45° field of view. 2184x1690 — 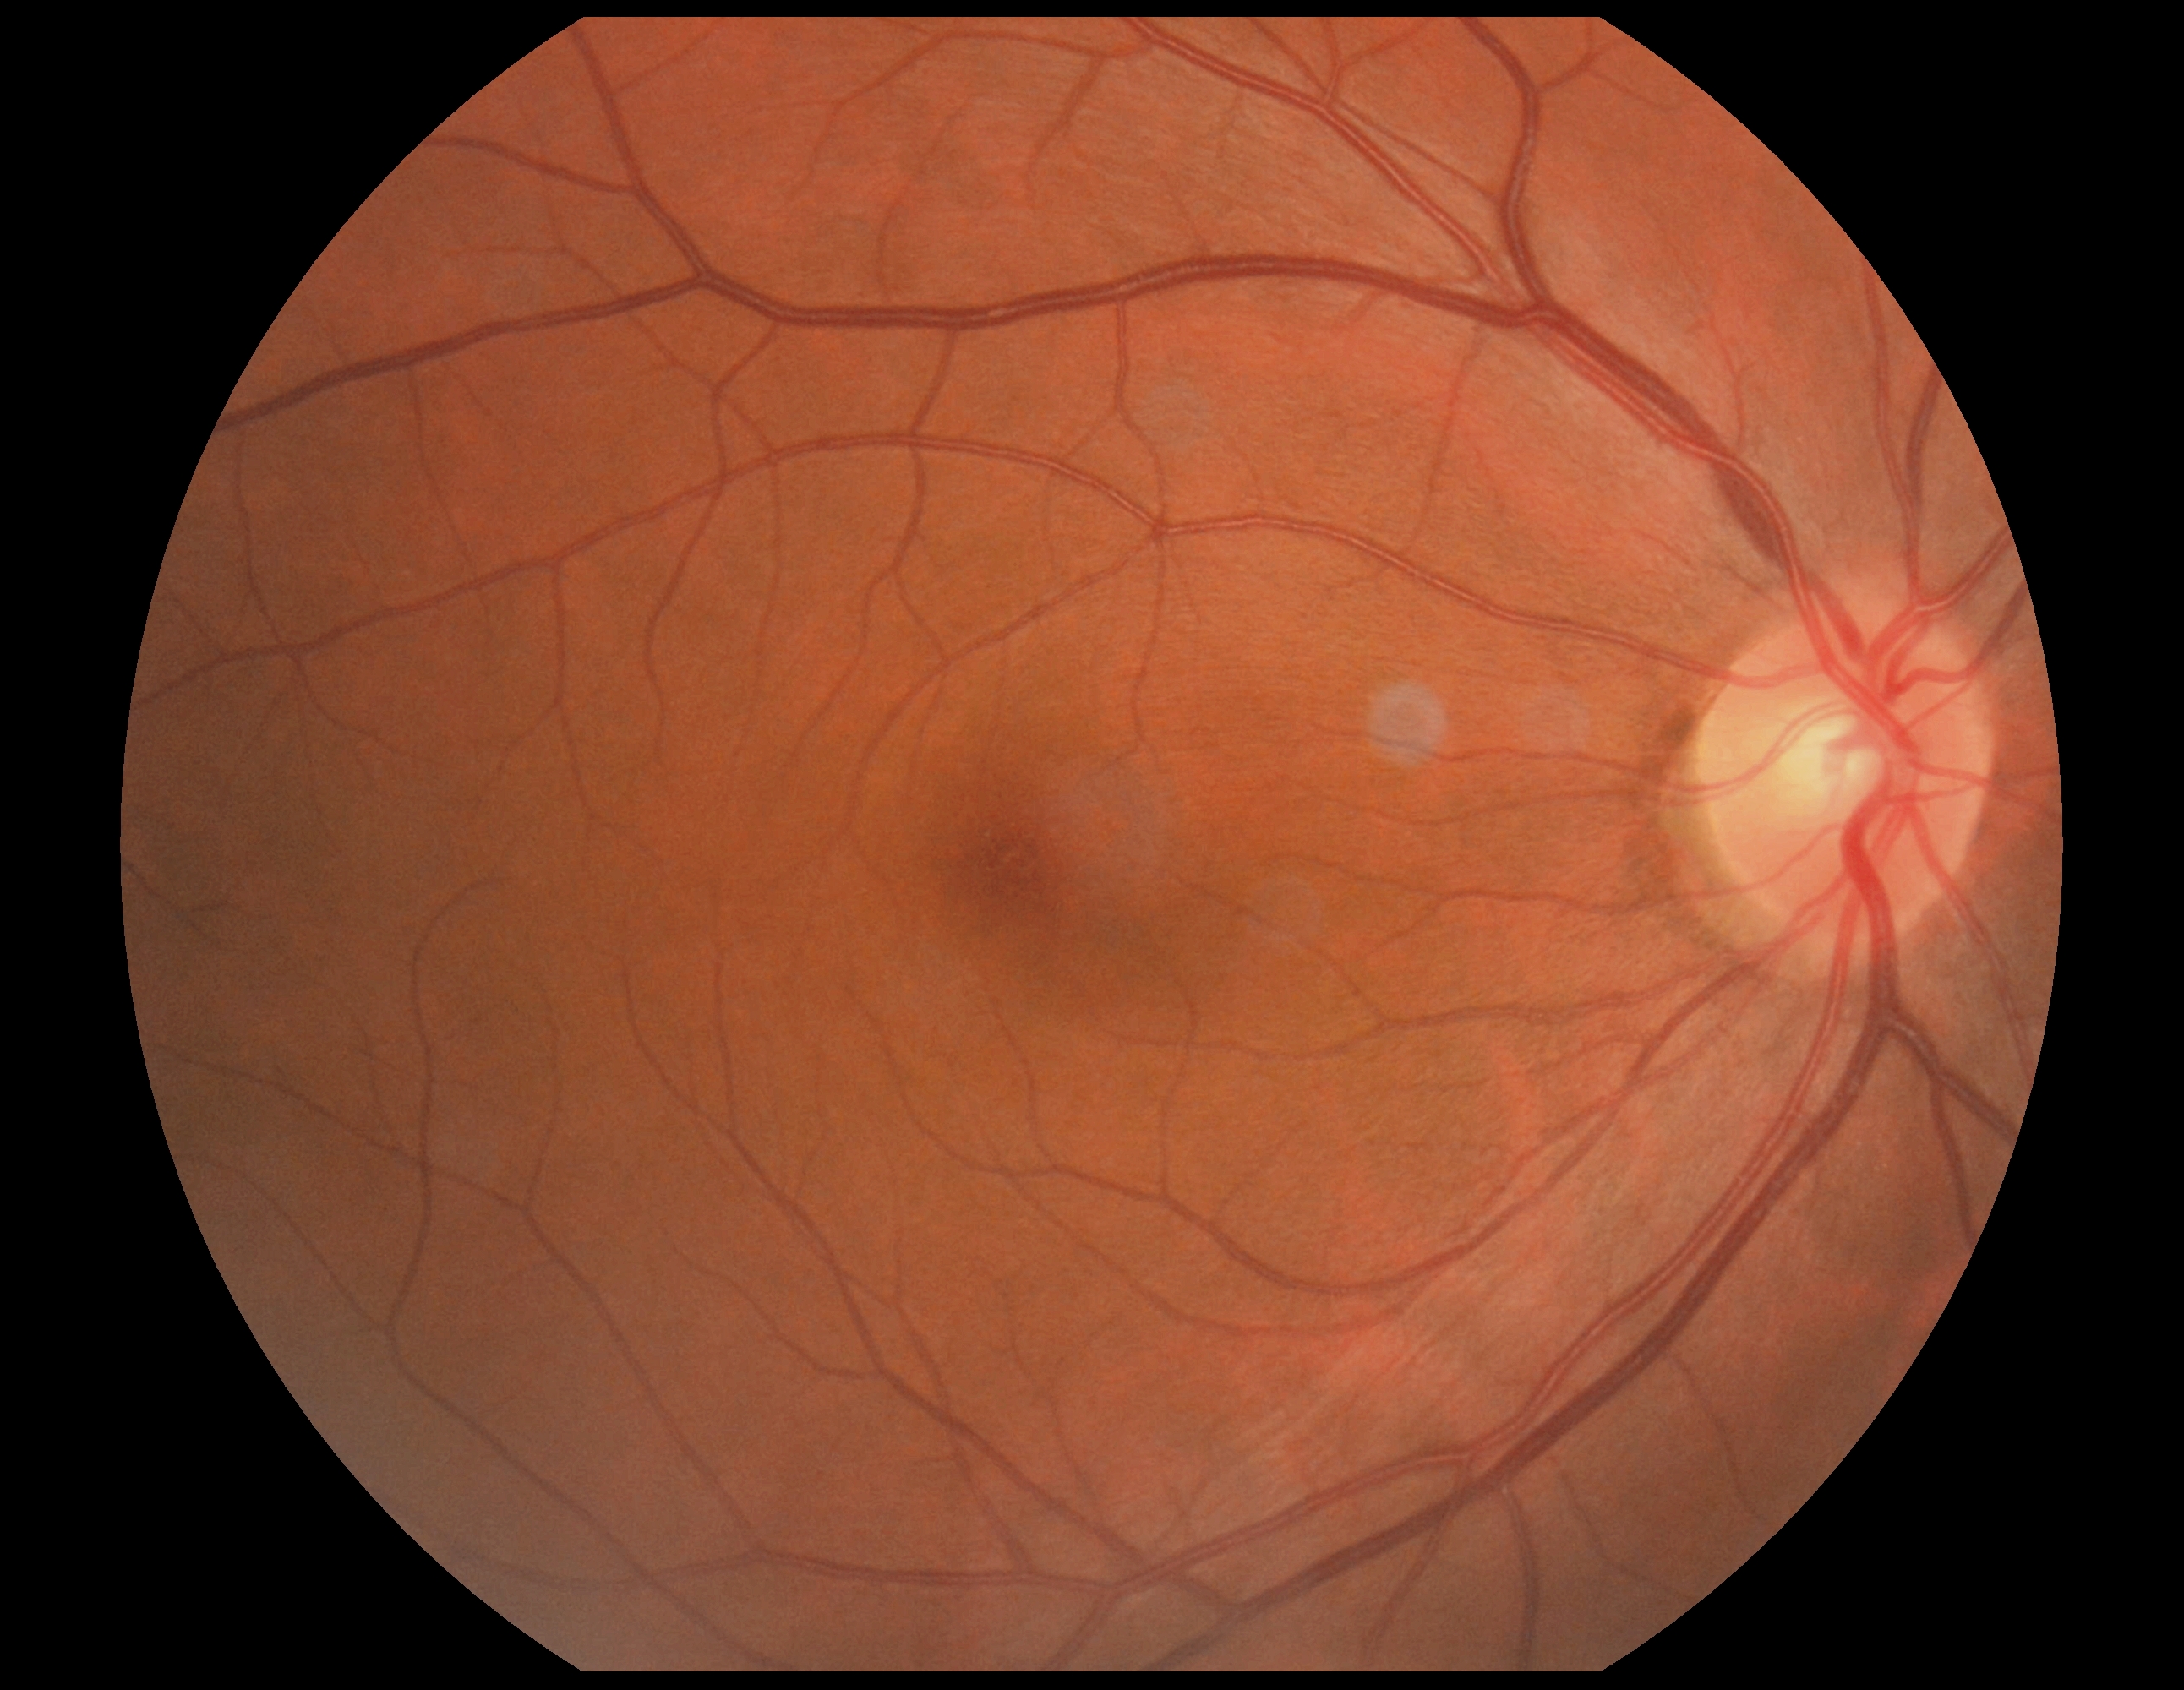

Retinopathy is grade 0 (no apparent retinopathy). No signs of diabetic retinopathy.